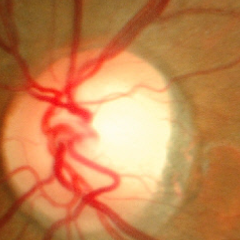

Glaucoma stage = no glaucomatous changes.